Image size 640x480 · wide-field fundus photograph from neonatal ROP screening: 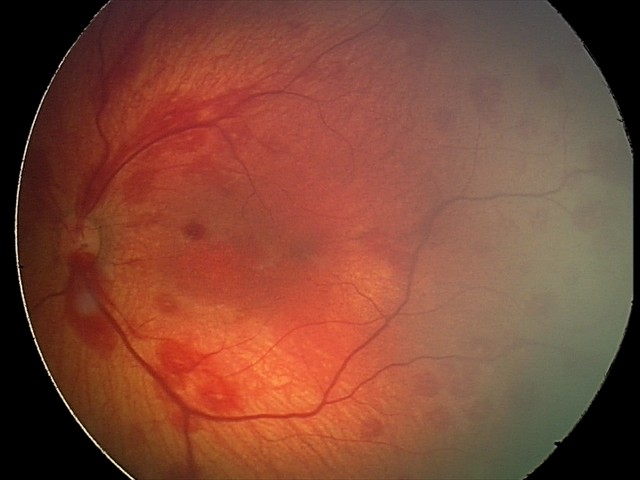 Screening examination consistent with retinal hemorrhages.